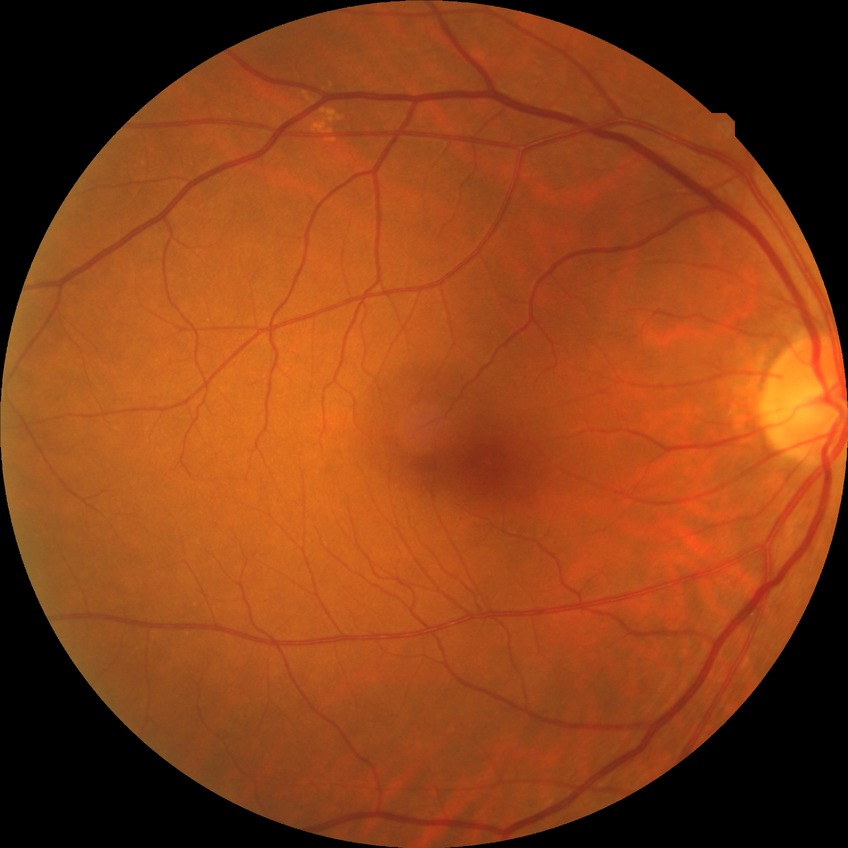 modified Davis classification@no diabetic retinopathy.